640x480px. Wide-field contact fundus photograph of an infant. Captured with the Clarity RetCam 3 (130° field of view) — 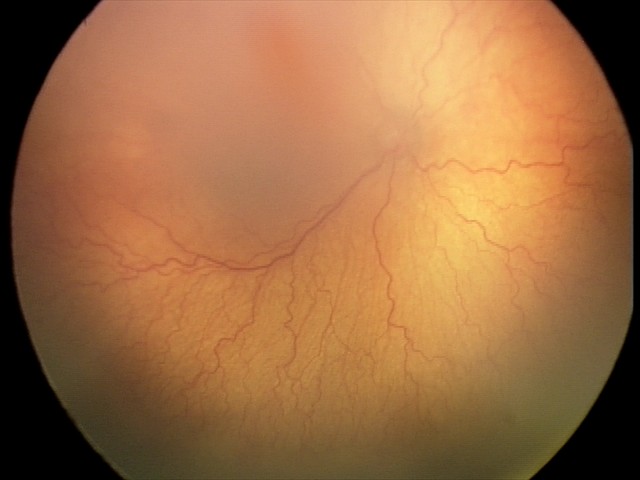
Screening: plus disease; aggressive retinopathy of prematurity — rapidly progressive severe ROP with prominent plus disease, often without classic stage progression.